Central posterior field; CFP: 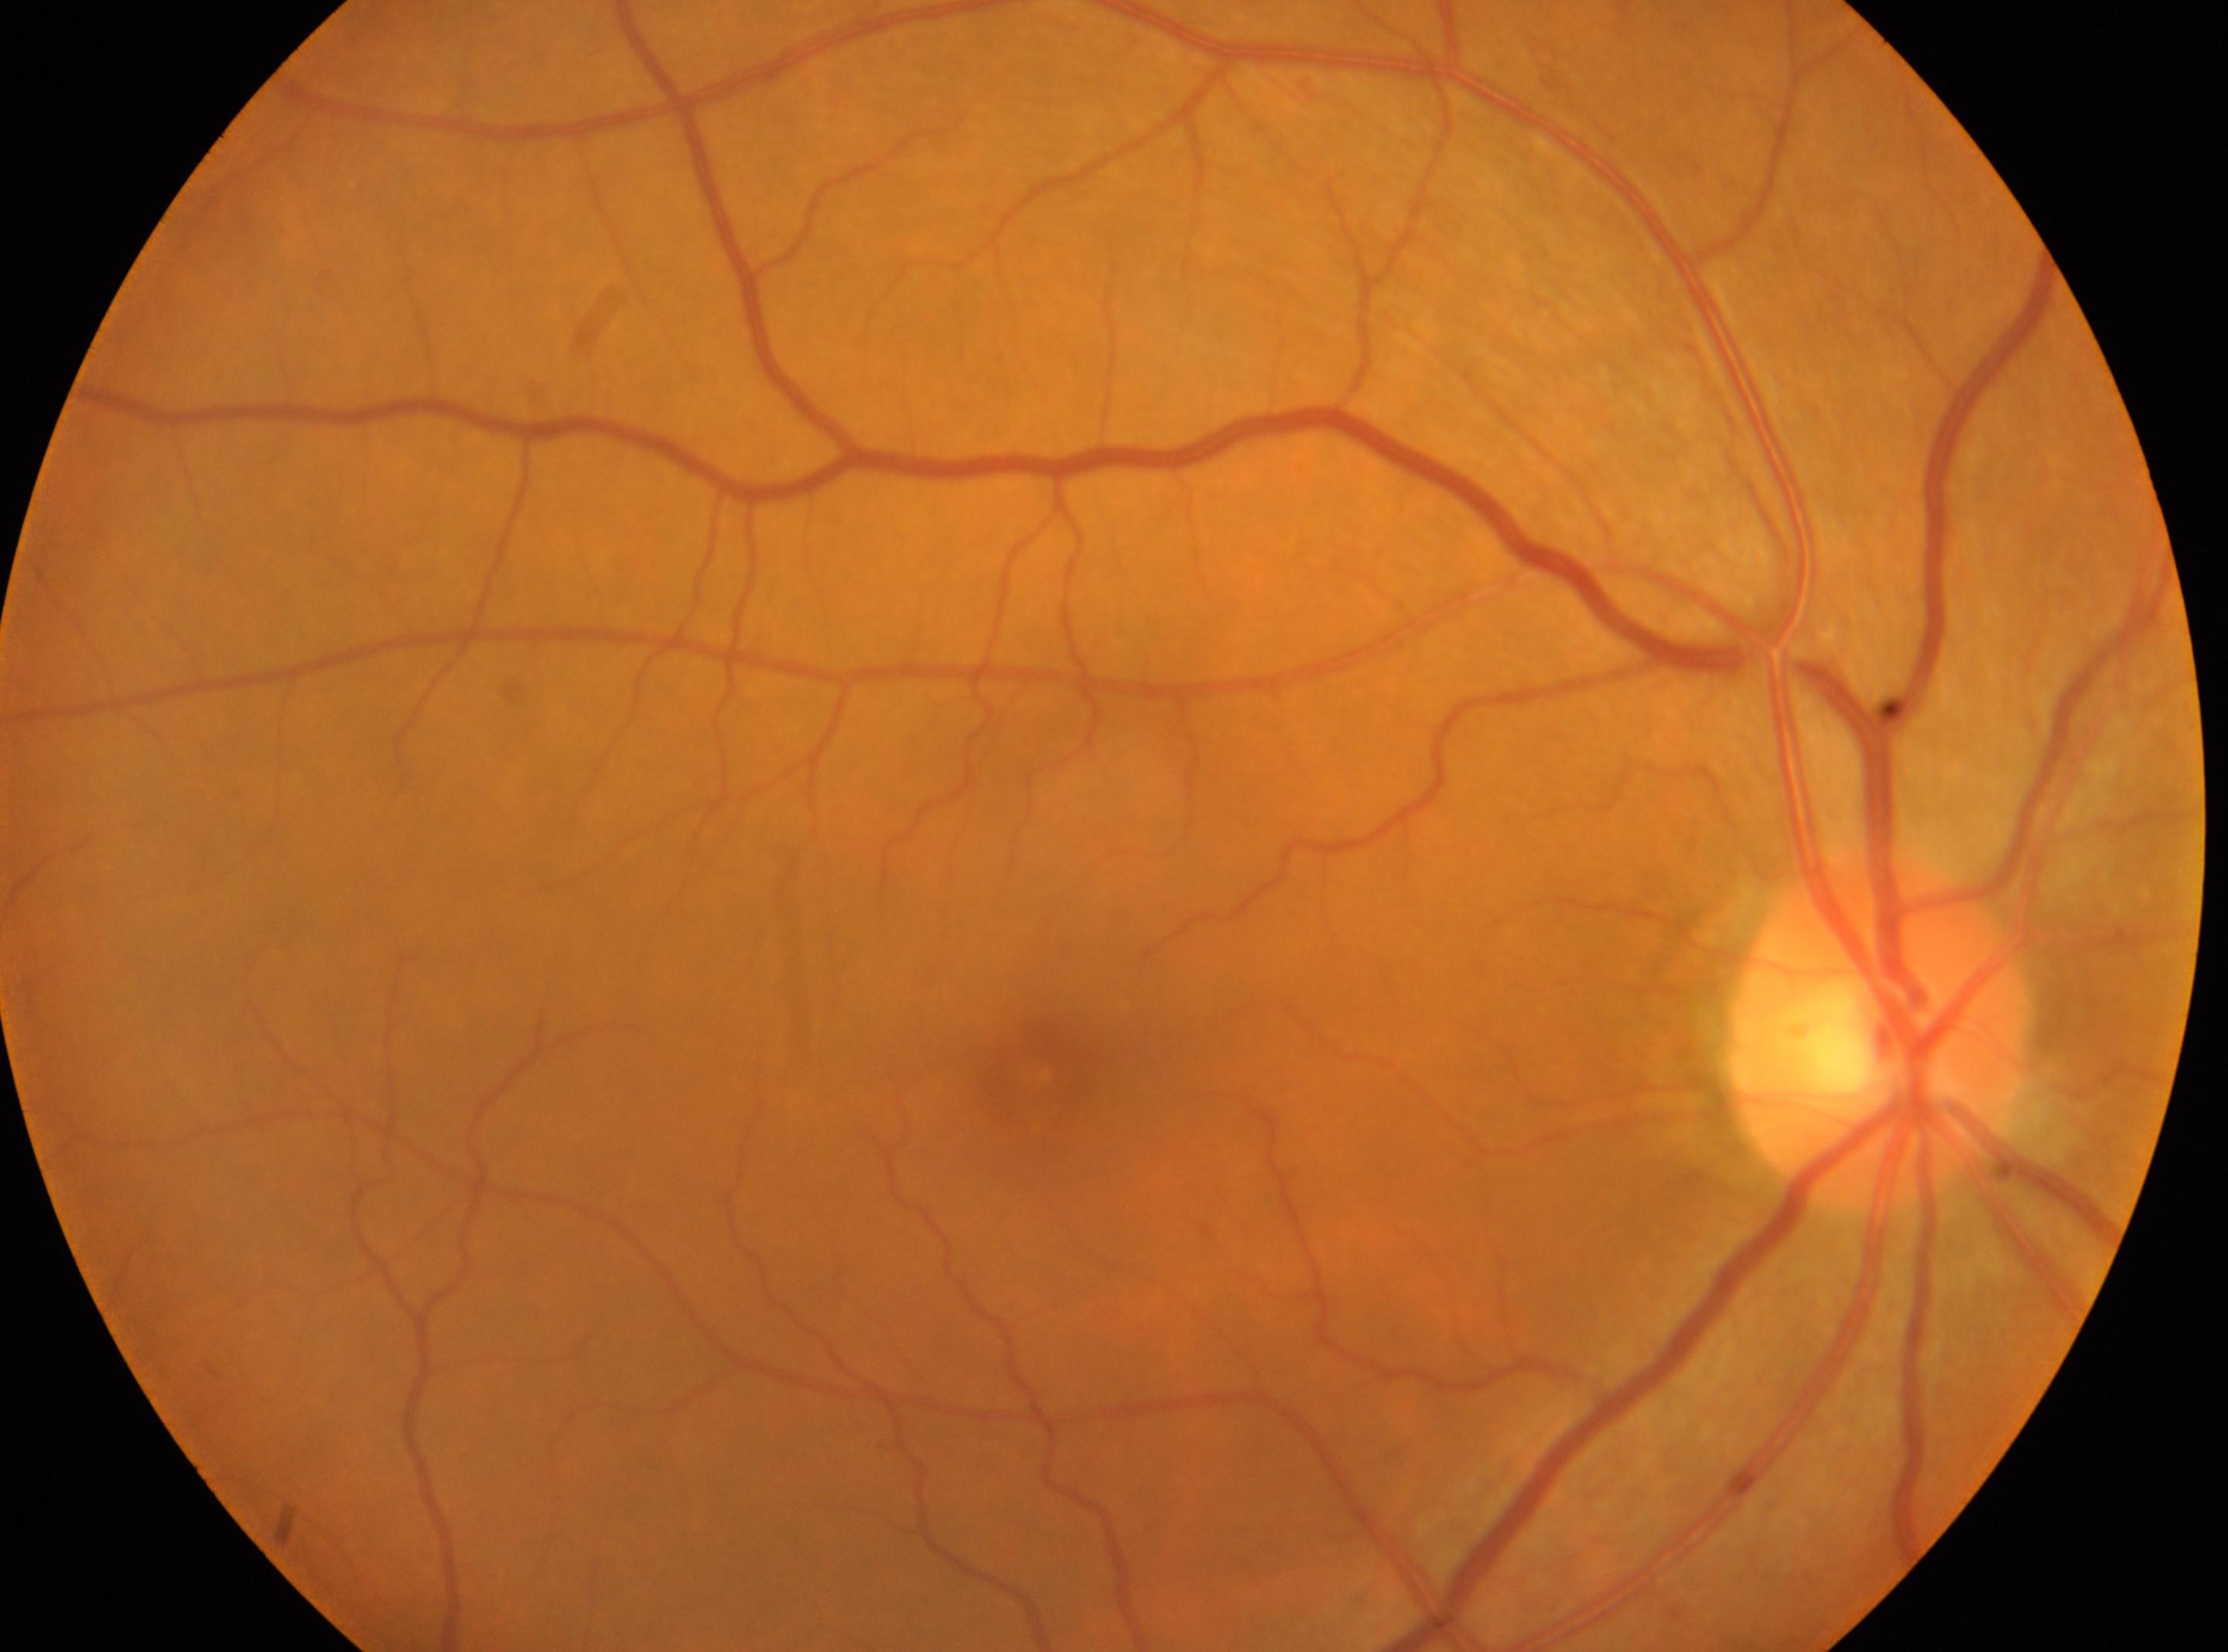

DR stage: grade 0. Macula center: 1037, 1072. Eye: oculus dexter. The ONH is at 1875, 1034.